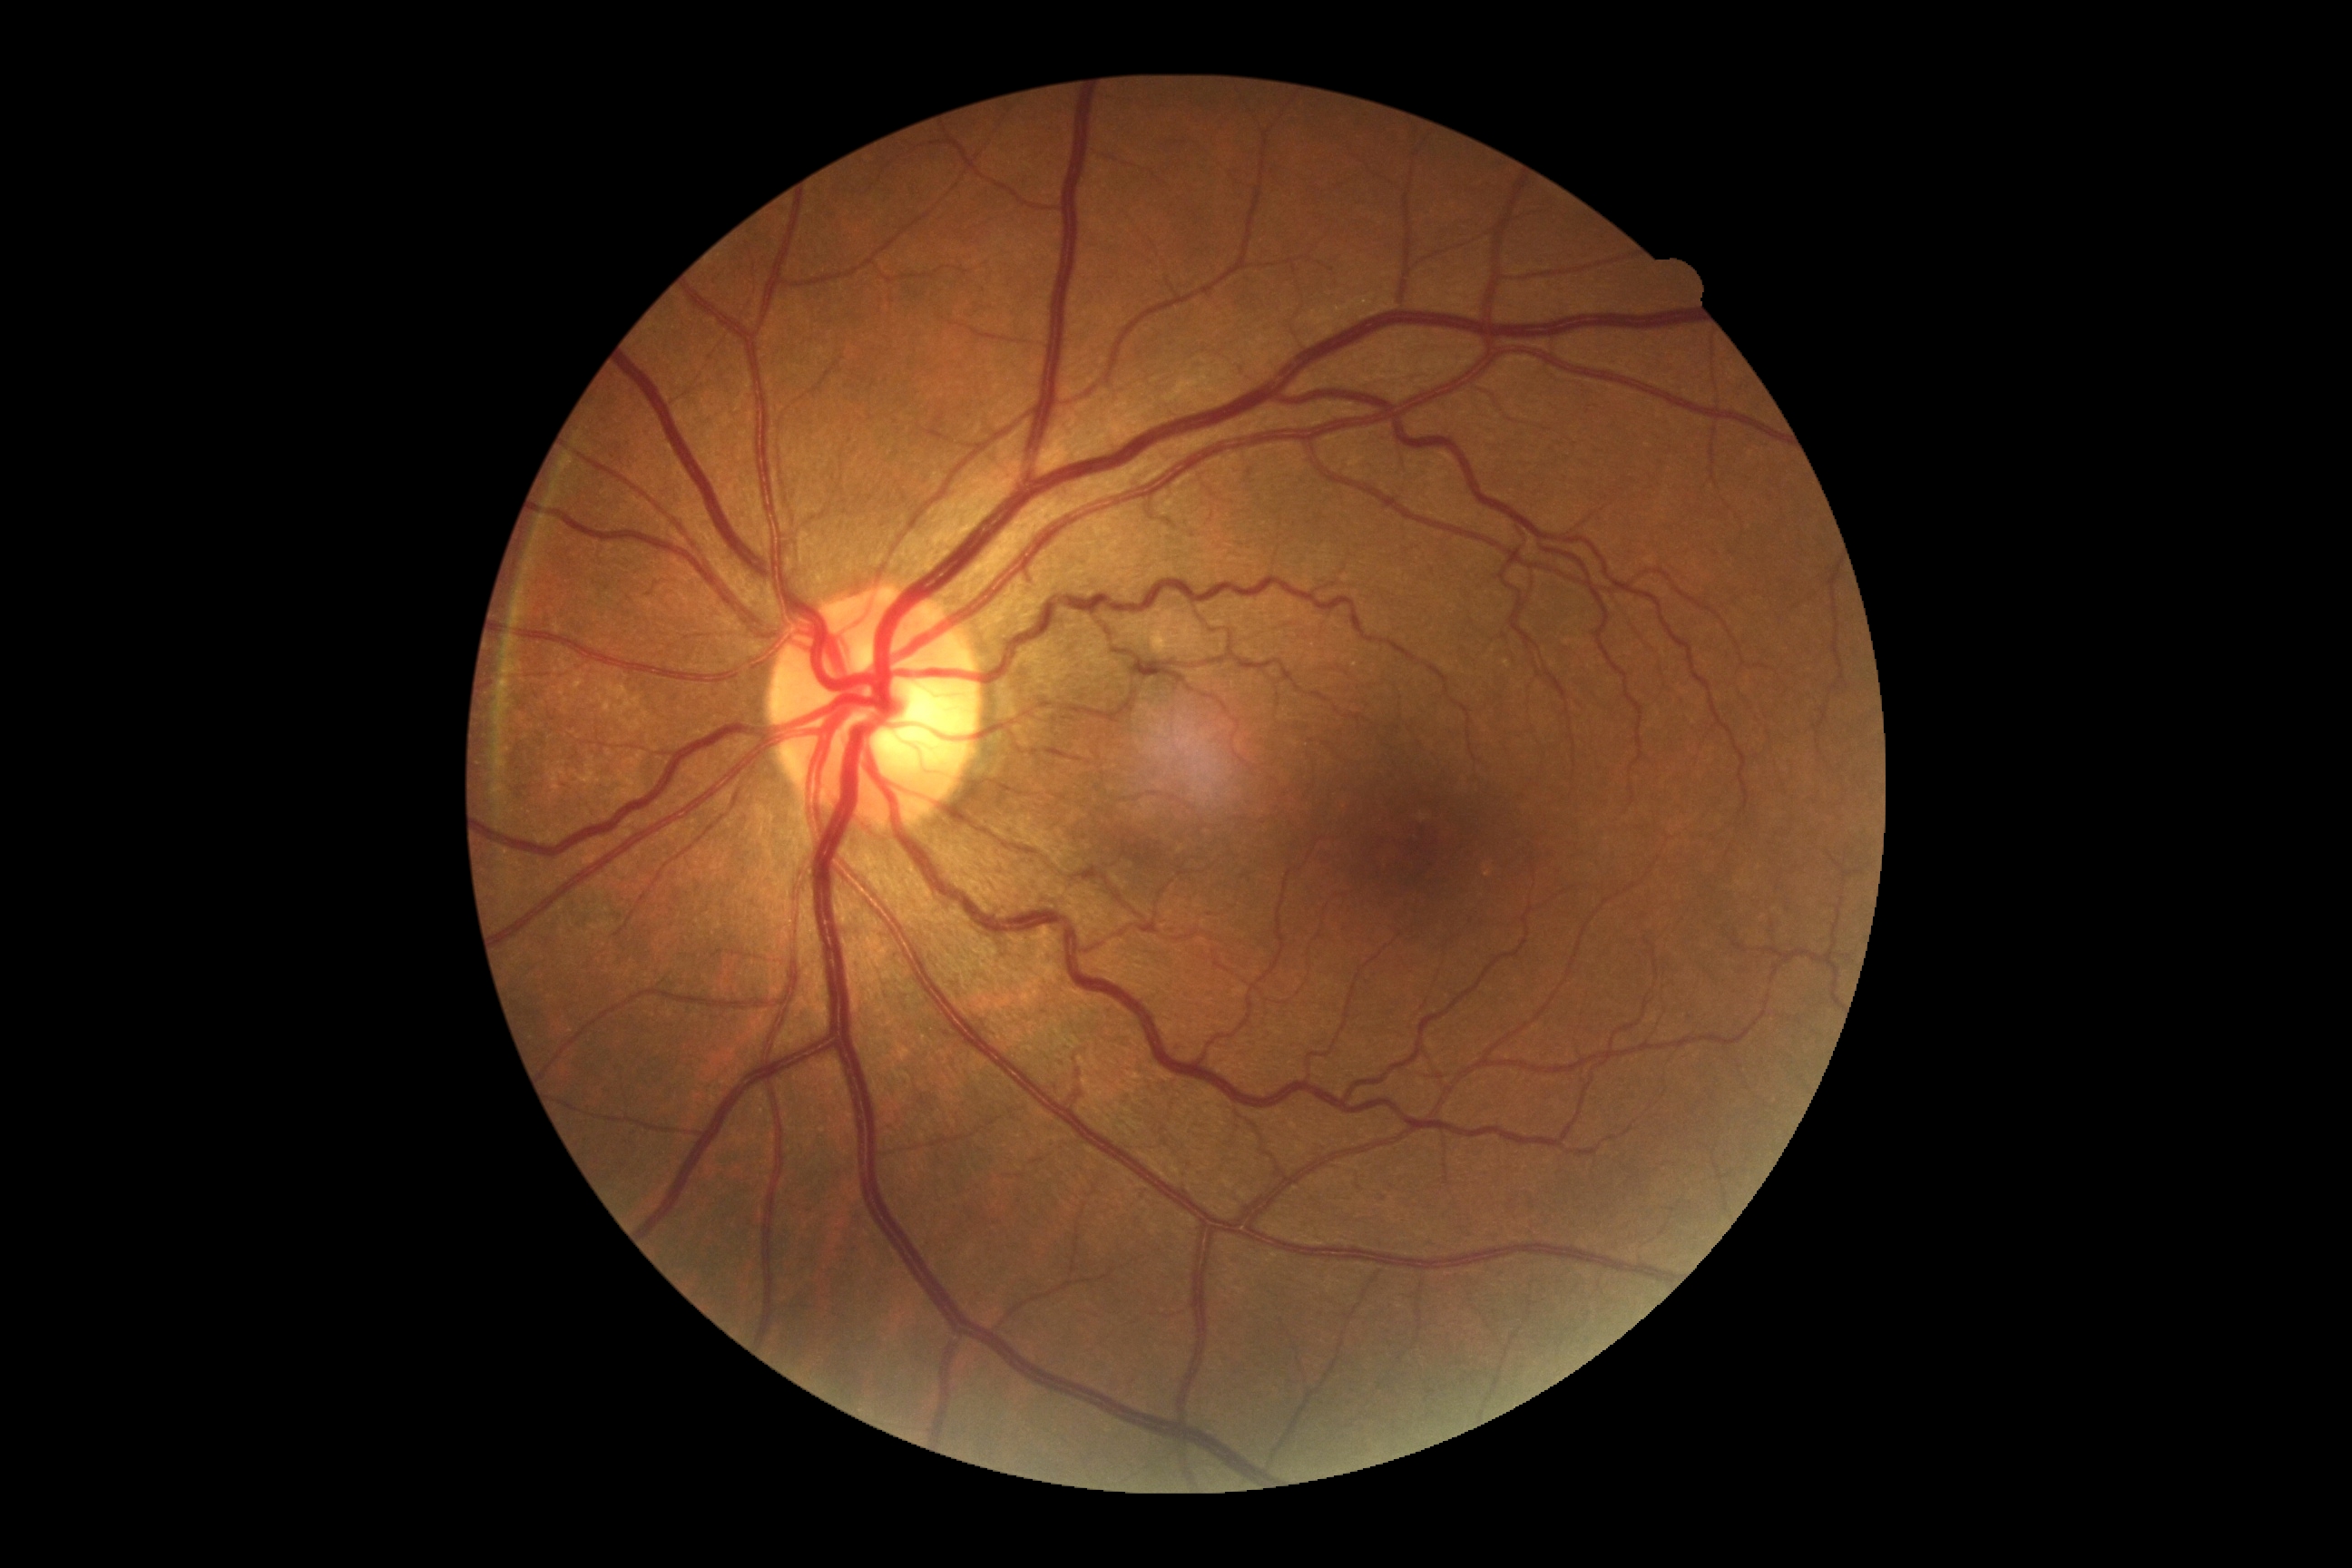

Diabetic retinopathy is 0/4.